45-degree field of view; 2352 by 1568 pixels
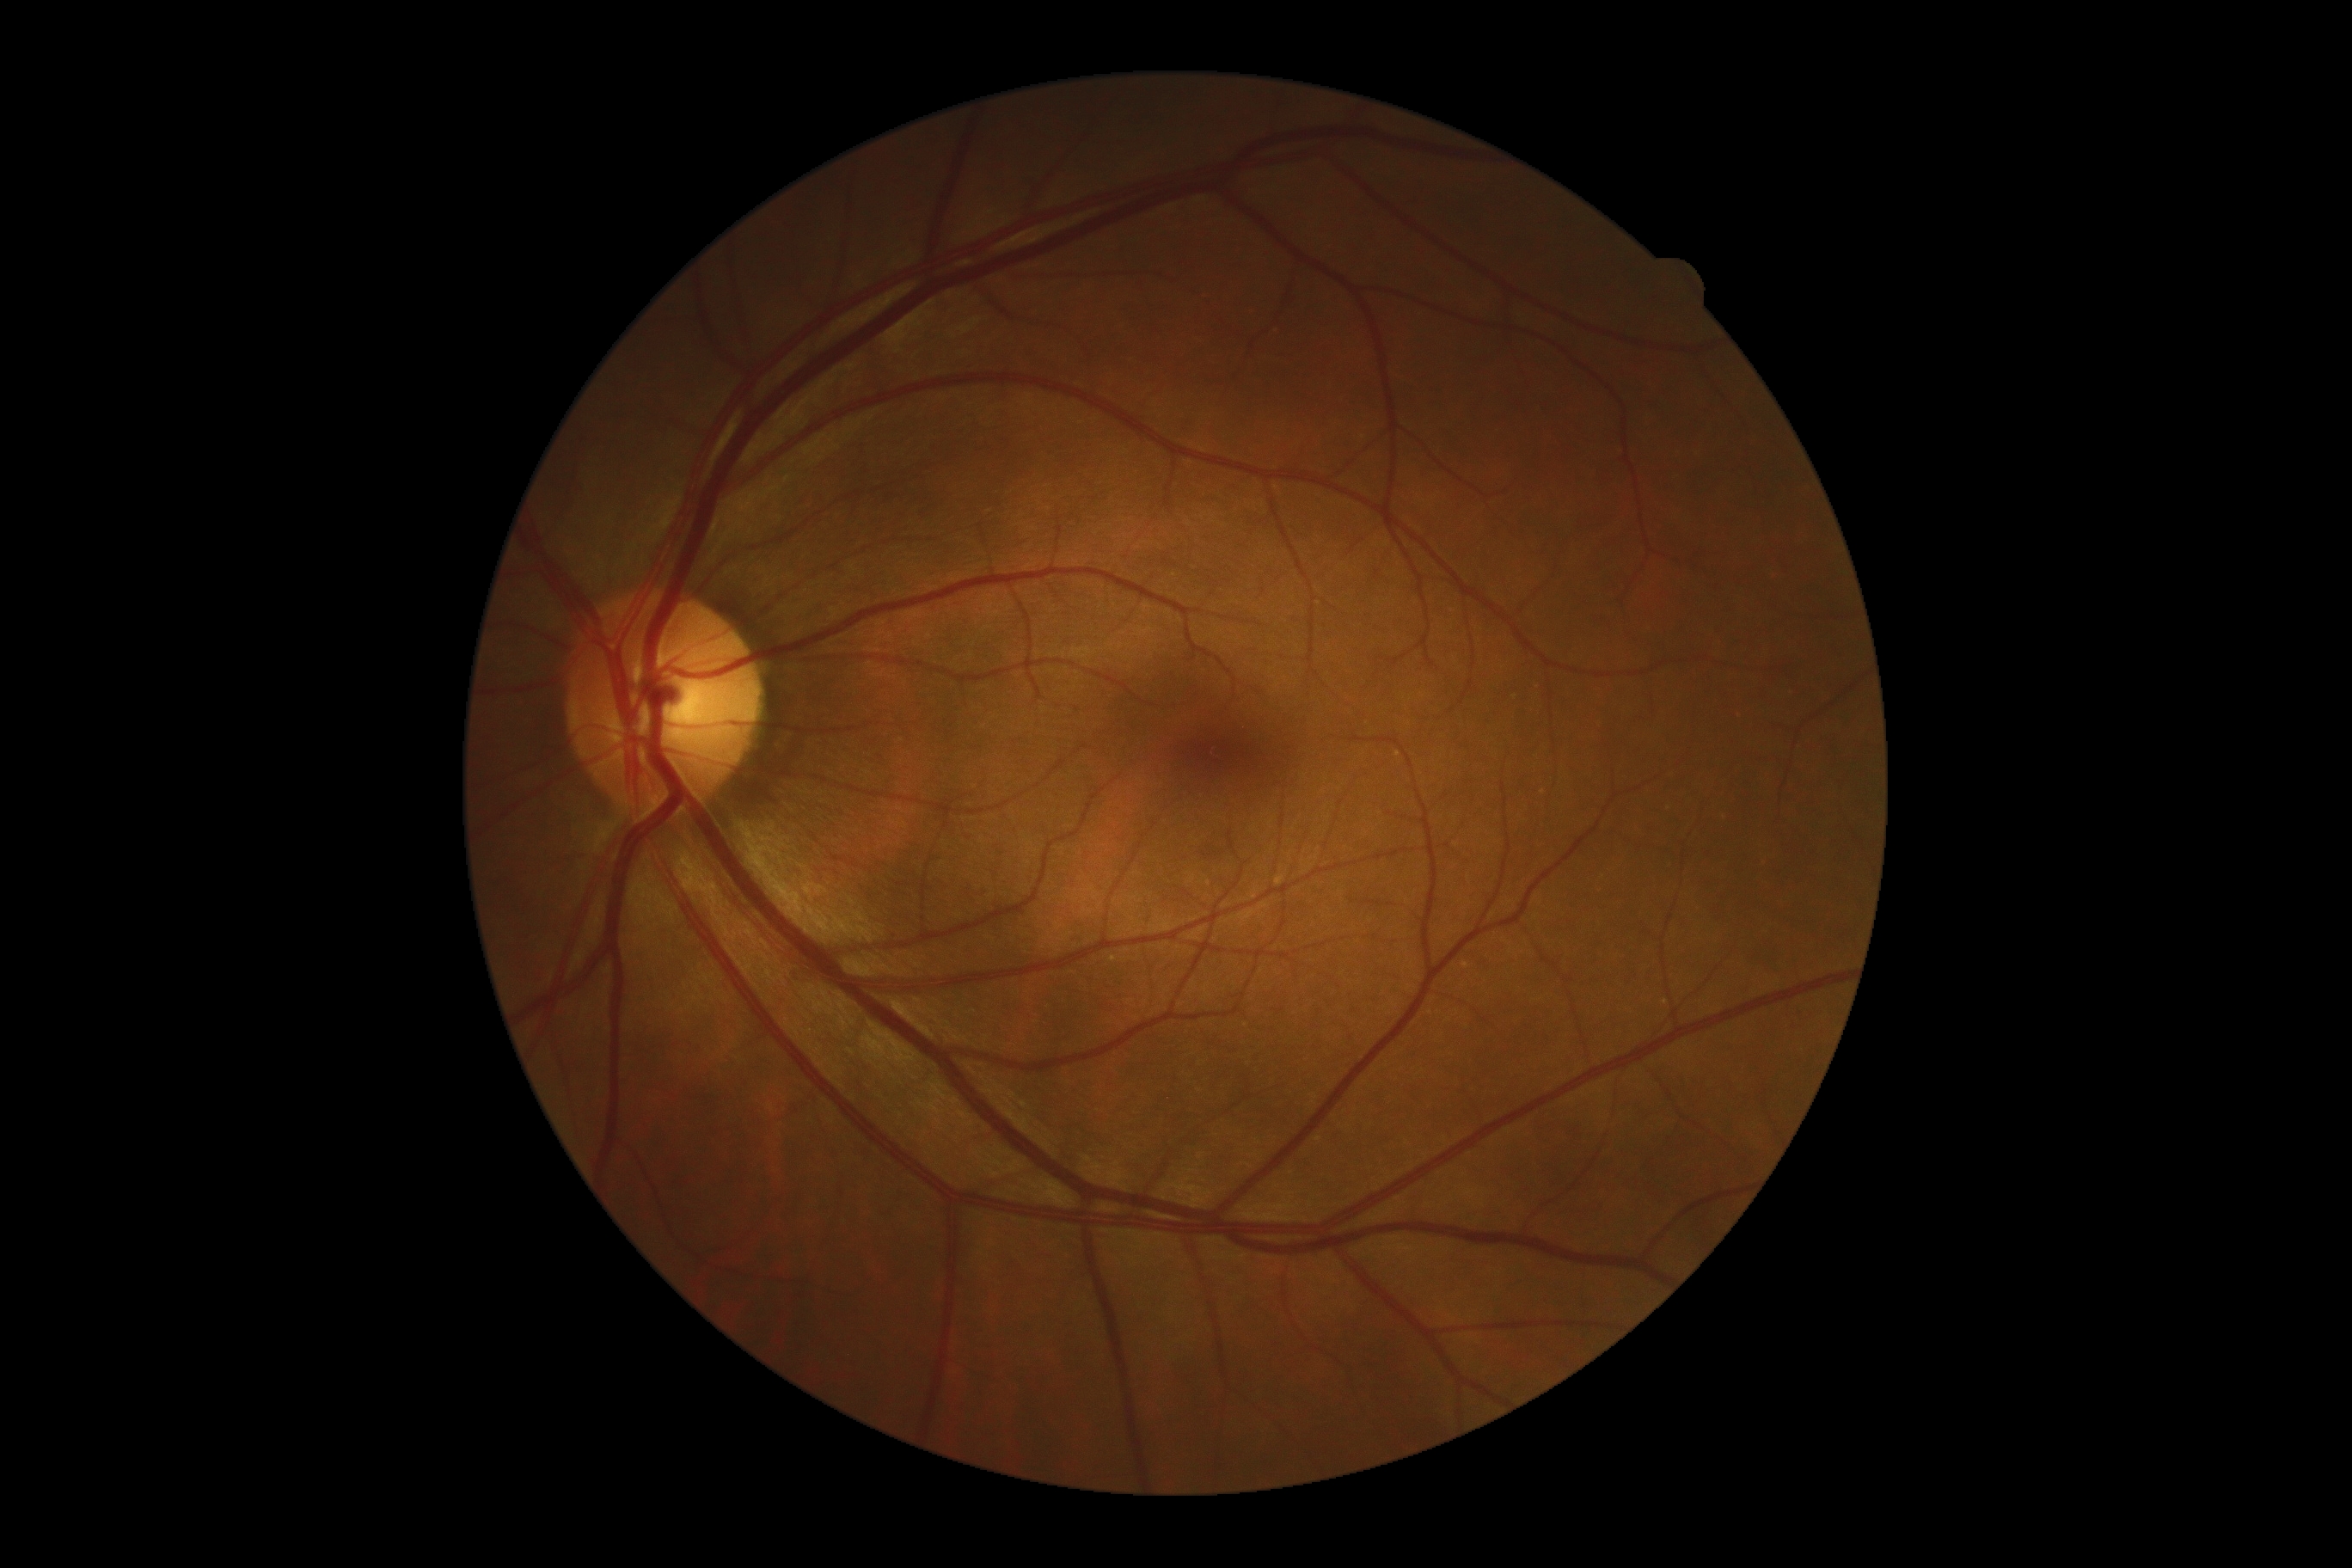

DR: grade 0.